Acquired with a NIDEK AFC-230 · 45° field of view · fundus photo · 848x848 · nonmydriatic fundus photograph:
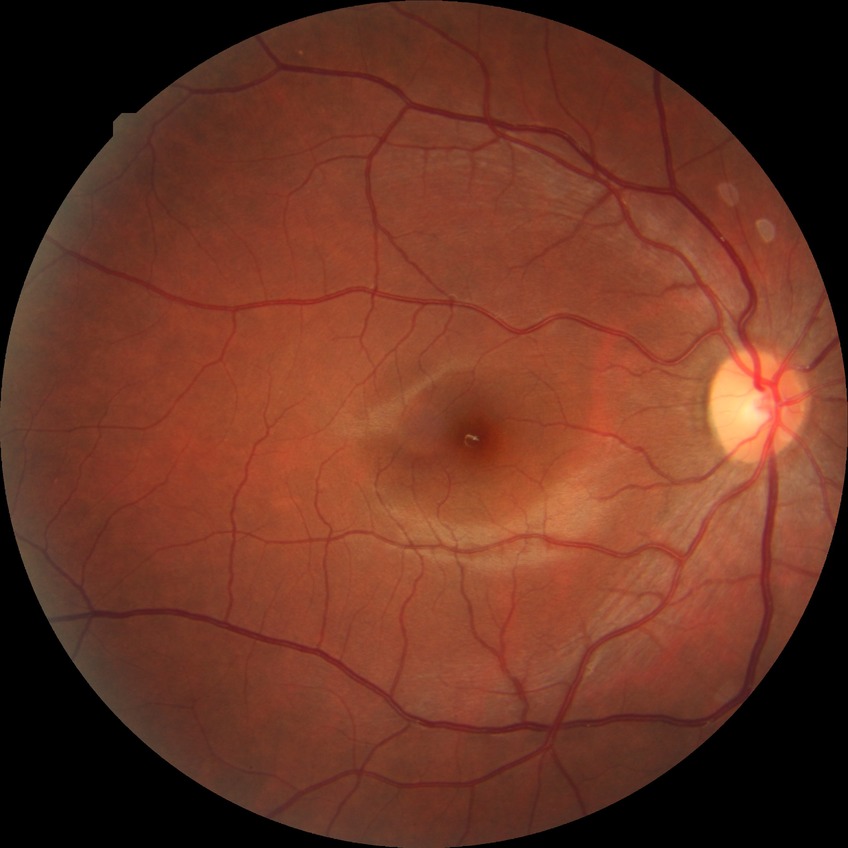
Davis DR grade@NDR, DR impression@no apparent DR.